2352x1568px.
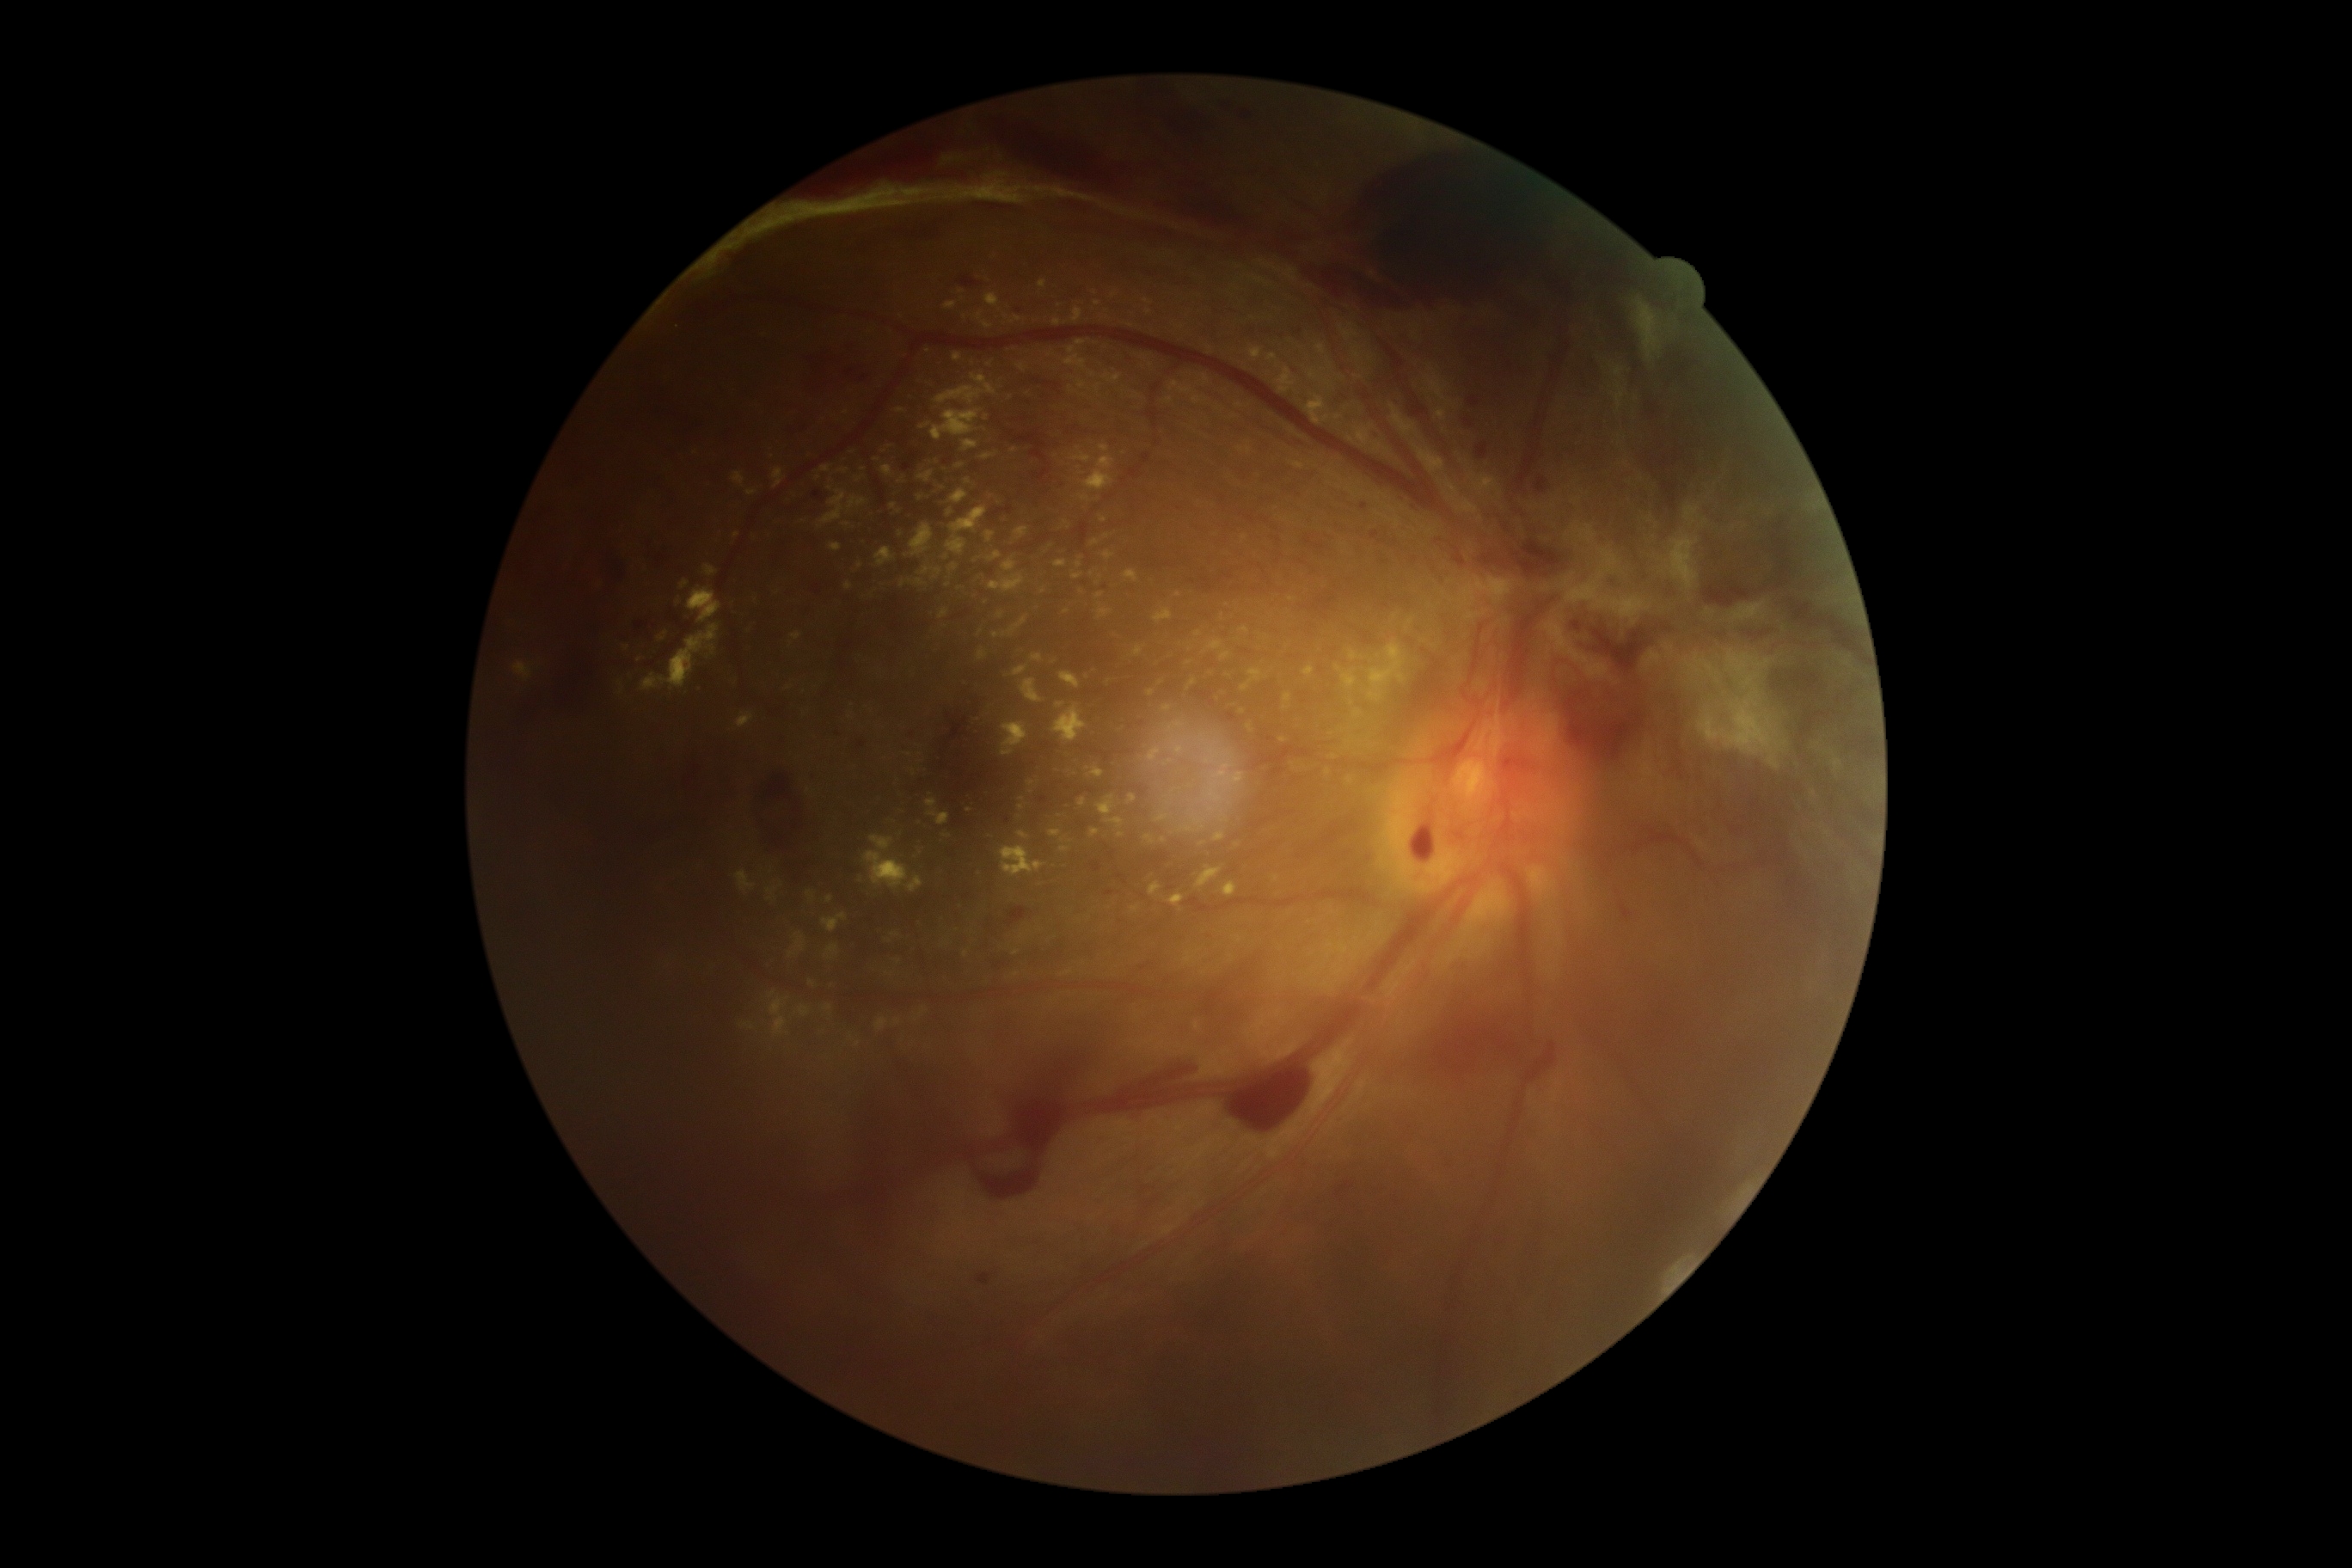

DR severity: grade 4.